No pharmacologic dilation, 848x848px — 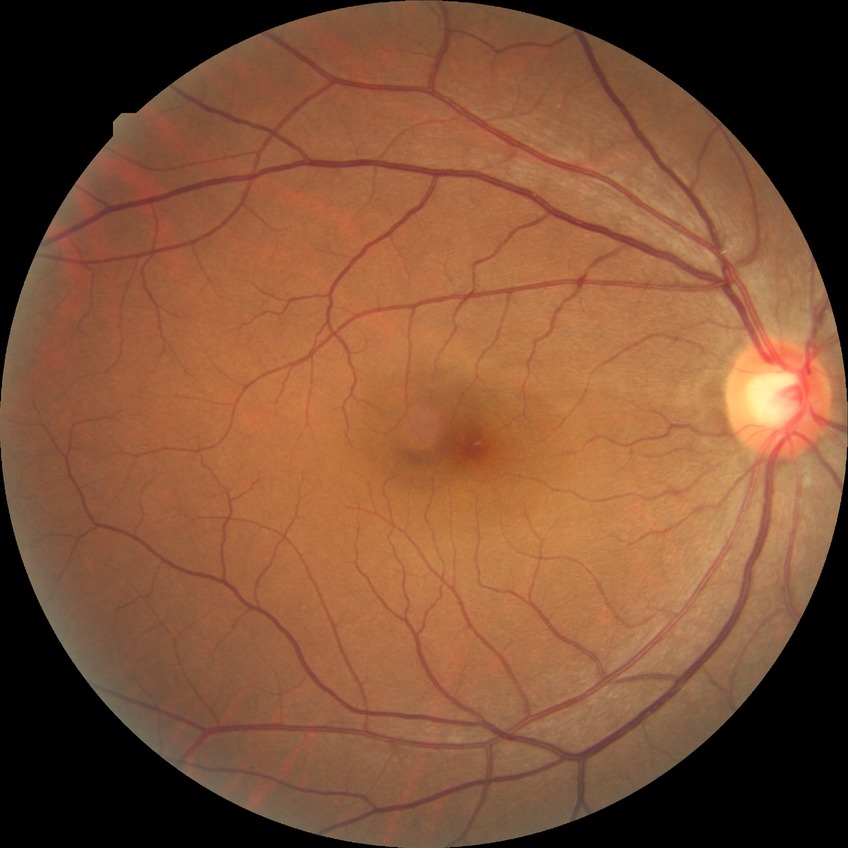

{"davis_grade": "no diabetic retinopathy"}